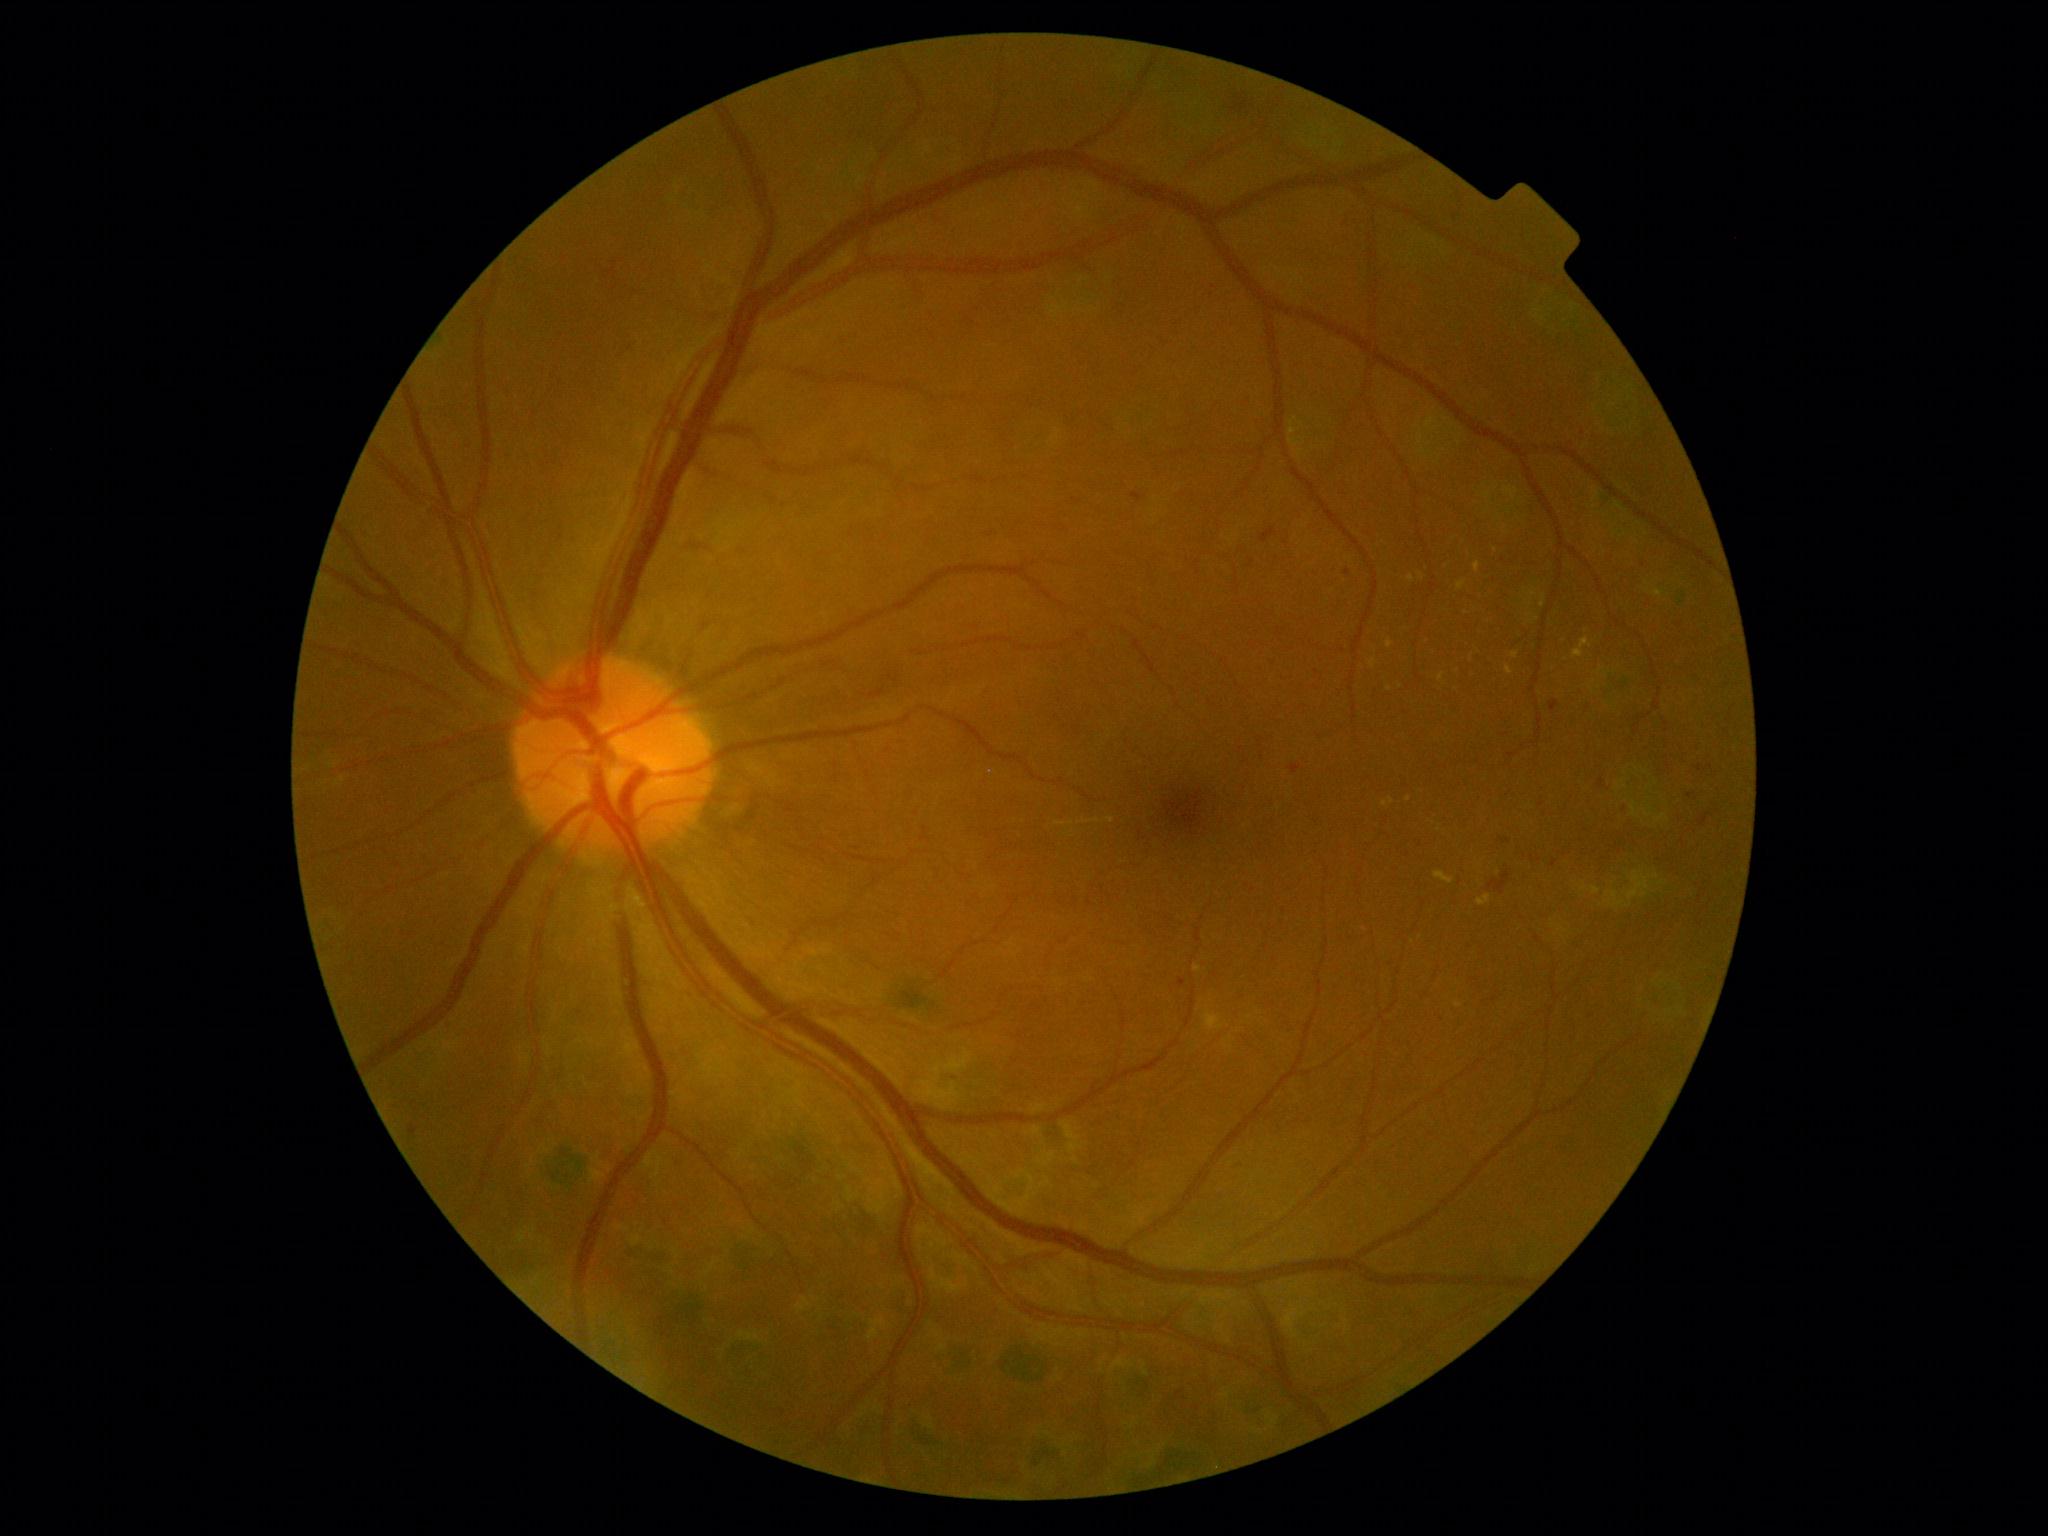
Diabetic retinopathy (DR) is 2/4
Selected lesions:
hard exudates (EXs) (subset): {"x1": 1474, "y1": 561, "x2": 1480, "y2": 573}; {"x1": 1387, "y1": 640, "x2": 1394, "y2": 649}; {"x1": 1512, "y1": 651, "x2": 1519, "y2": 659}; {"x1": 1408, "y1": 576, "x2": 1416, "y2": 583}; {"x1": 1055, "y1": 822, "x2": 1066, "y2": 826}; {"x1": 1383, "y1": 798, "x2": 1394, "y2": 808}; {"x1": 1434, "y1": 872, "x2": 1454, "y2": 885}; {"x1": 1205, "y1": 1009, "x2": 1224, "y2": 1031}
Smaller EXs around <point>1111, 820</point>; <point>1072, 823</point>; <point>1648, 590</point>; <point>1422, 577</point>
hemorrhages (HEs): {"x1": 1487, "y1": 872, "x2": 1510, "y2": 895}
soft exudates (SEs): not present
microaneurysms (MAs): {"x1": 1696, "y1": 765, "x2": 1704, "y2": 772}; {"x1": 1598, "y1": 779, "x2": 1606, "y2": 789}; {"x1": 1702, "y1": 815, "x2": 1708, "y2": 823}; {"x1": 1132, "y1": 493, "x2": 1145, "y2": 503}; {"x1": 1622, "y1": 803, "x2": 1630, "y2": 813}; {"x1": 1550, "y1": 700, "x2": 1560, "y2": 712}; {"x1": 1262, "y1": 534, "x2": 1271, "y2": 541}; {"x1": 1290, "y1": 765, "x2": 1302, "y2": 775}; {"x1": 1552, "y1": 859, "x2": 1557, "y2": 868}; {"x1": 1178, "y1": 978, "x2": 1186, "y2": 987}; {"x1": 1497, "y1": 836, "x2": 1510, "y2": 845}; {"x1": 408, "y1": 1124, "x2": 418, "y2": 1136}
Smaller MAs around <point>1644, 565</point>; <point>1691, 796</point>; <point>1348, 573</point>